Ultra-widefield fundus mosaic.
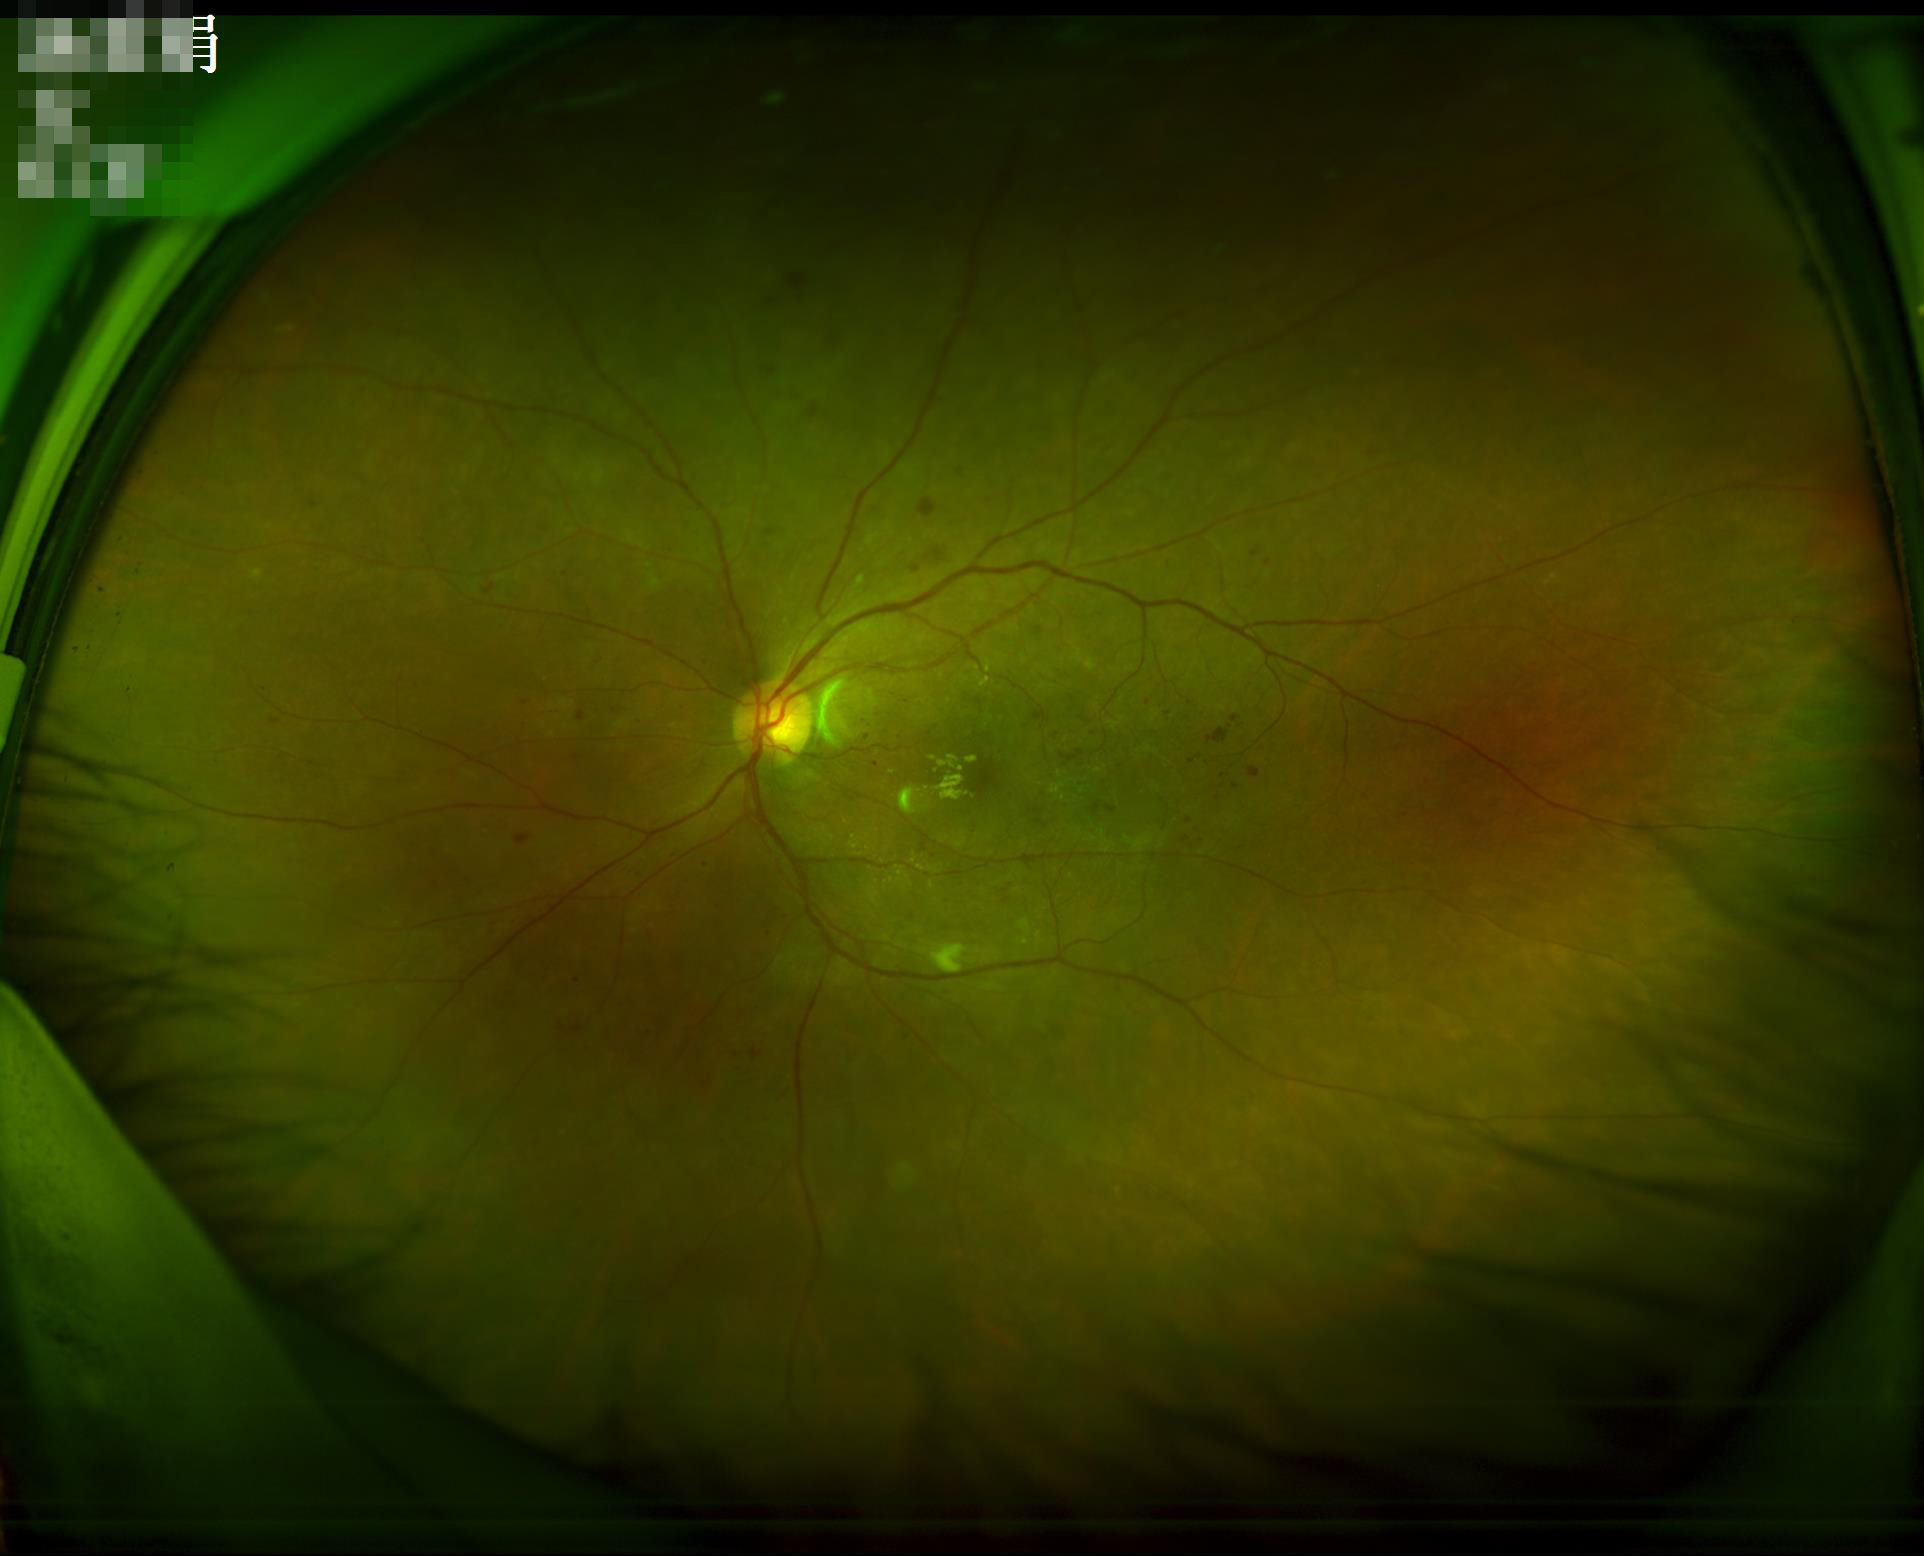

Image quality assessment: focus: in focus | overall: adequate | contrast: satisfactory.